Diabetic retinopathy graded by the modified Davis classification · NIDEK AFC-230 fundus camera: 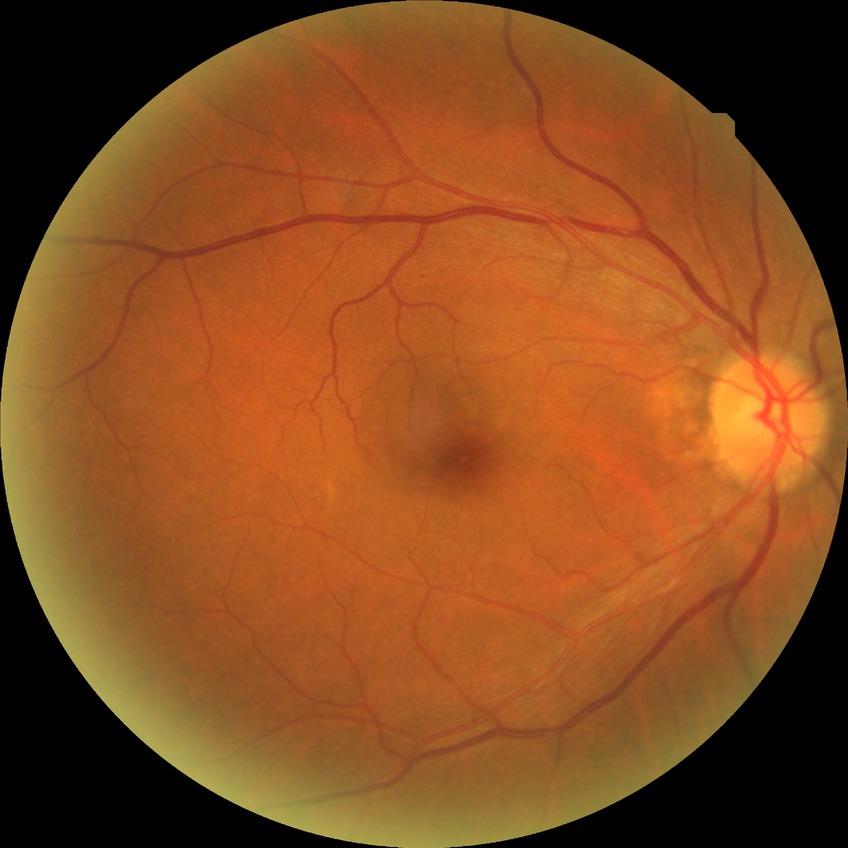
Diabetic retinopathy grade is no diabetic retinopathy.